Clarity RetCam 3, 130° FOV · 640 by 480 pixels · infant wide-field retinal image.
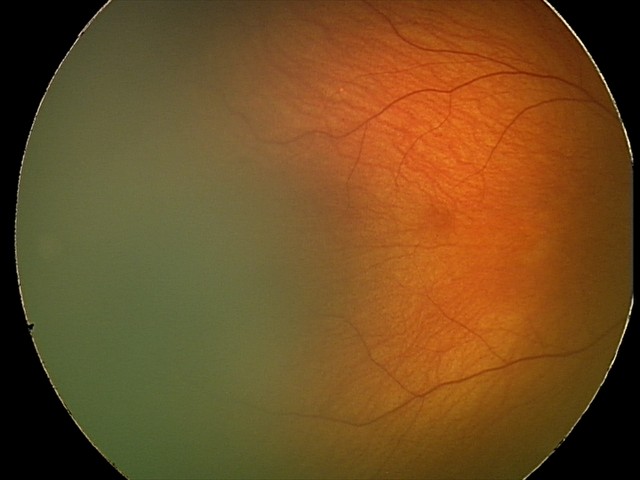
Screening examination diagnosed as physiological.